45-degree field of view; color fundus photograph; 2184 by 1682 pixels:
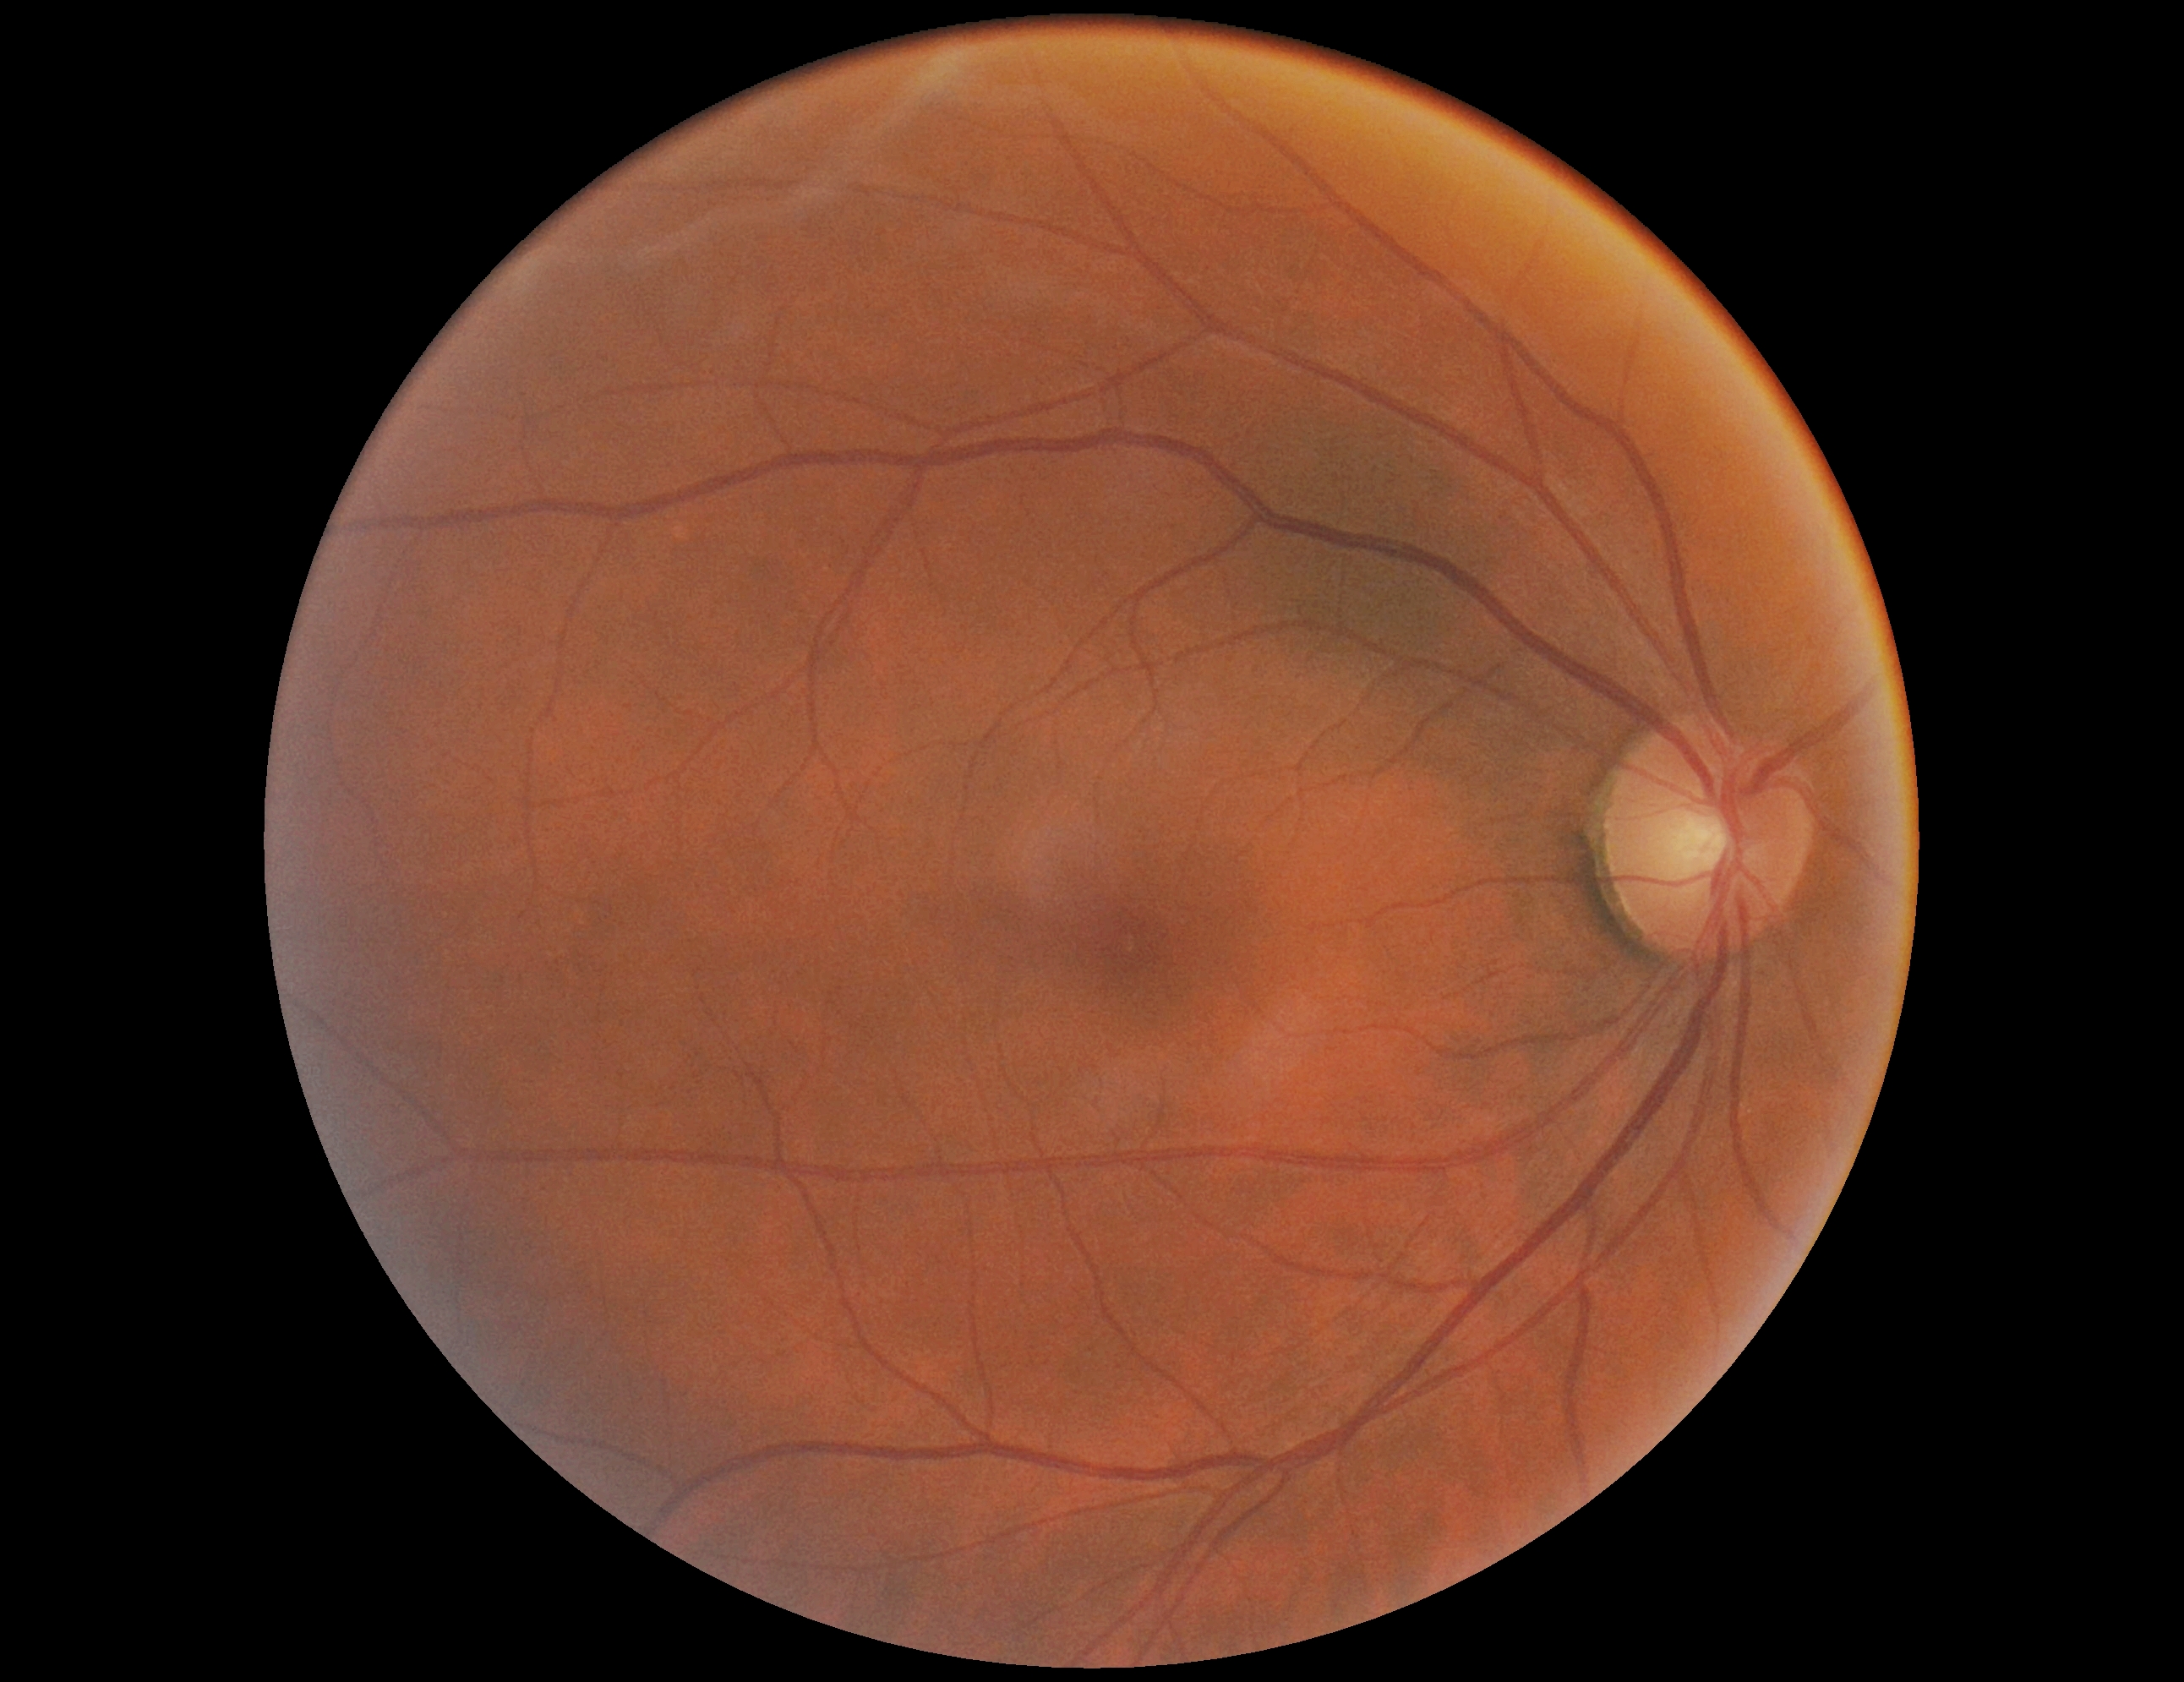 diabetic retinopathy severity: no apparent retinopathy (grade 0)